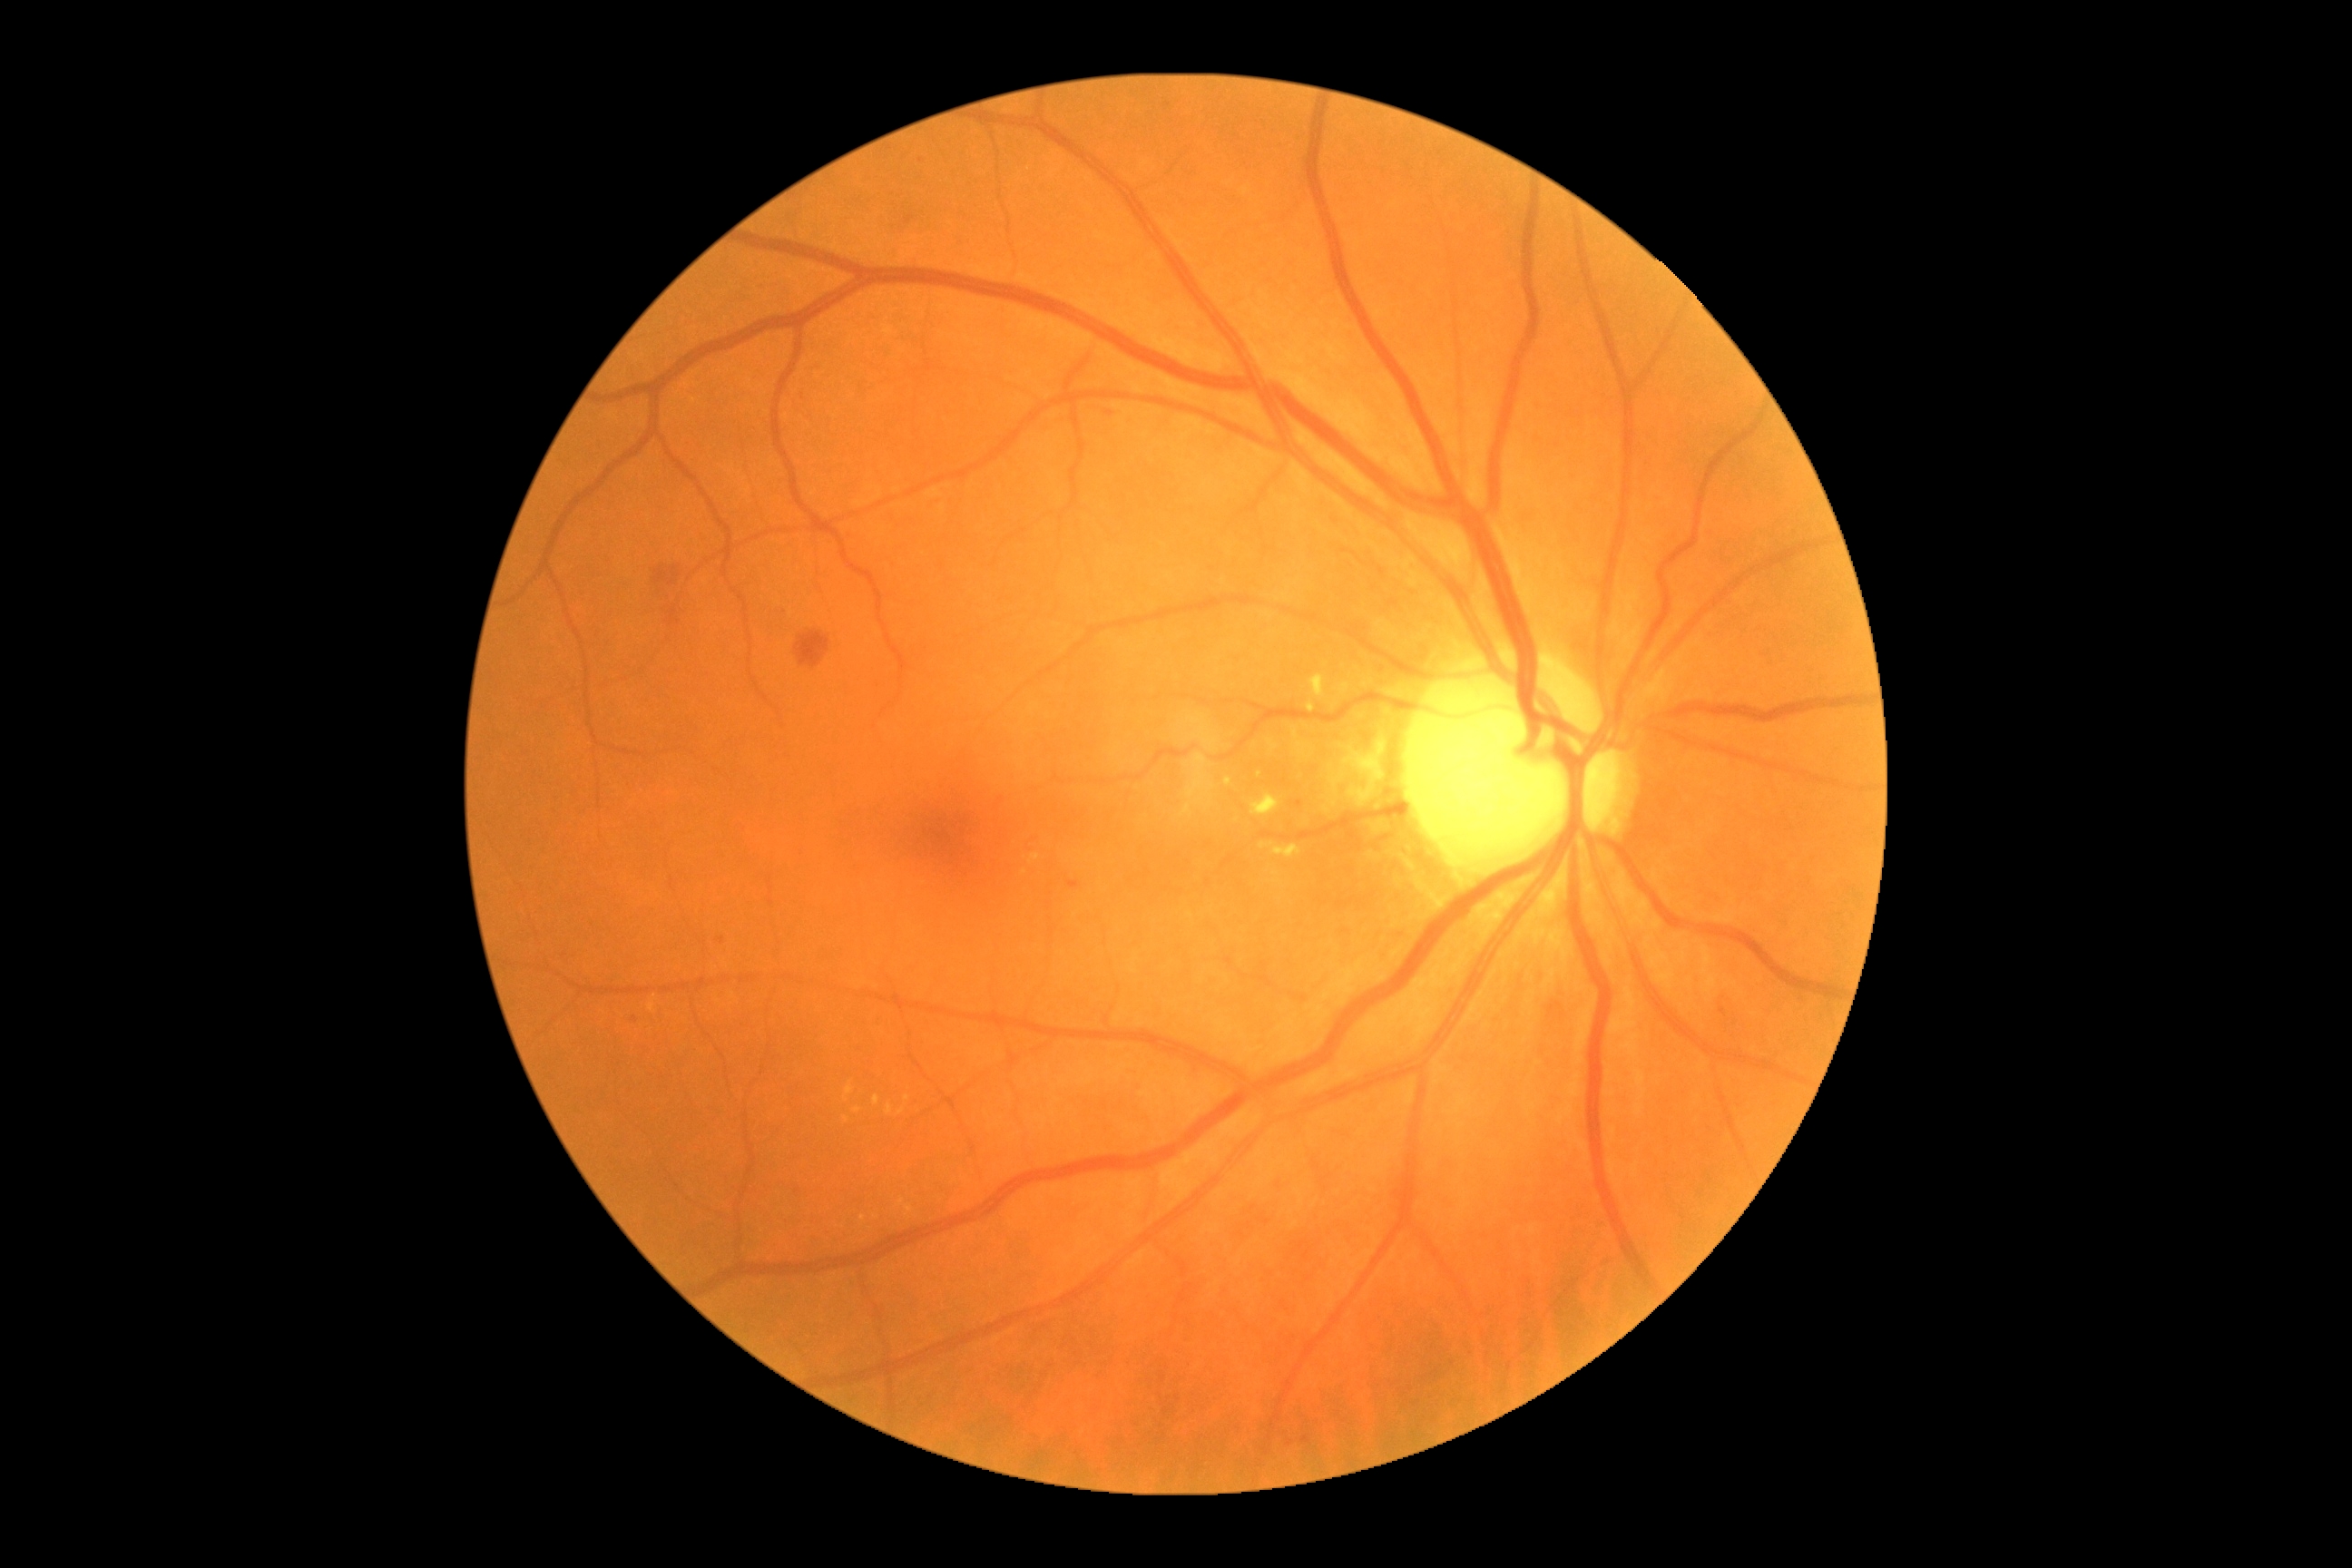
Diabetic retinopathy grade: 2/4 — more than just microaneurysms but less than severe NPDR.